FOV: 45 degrees · color fundus image — 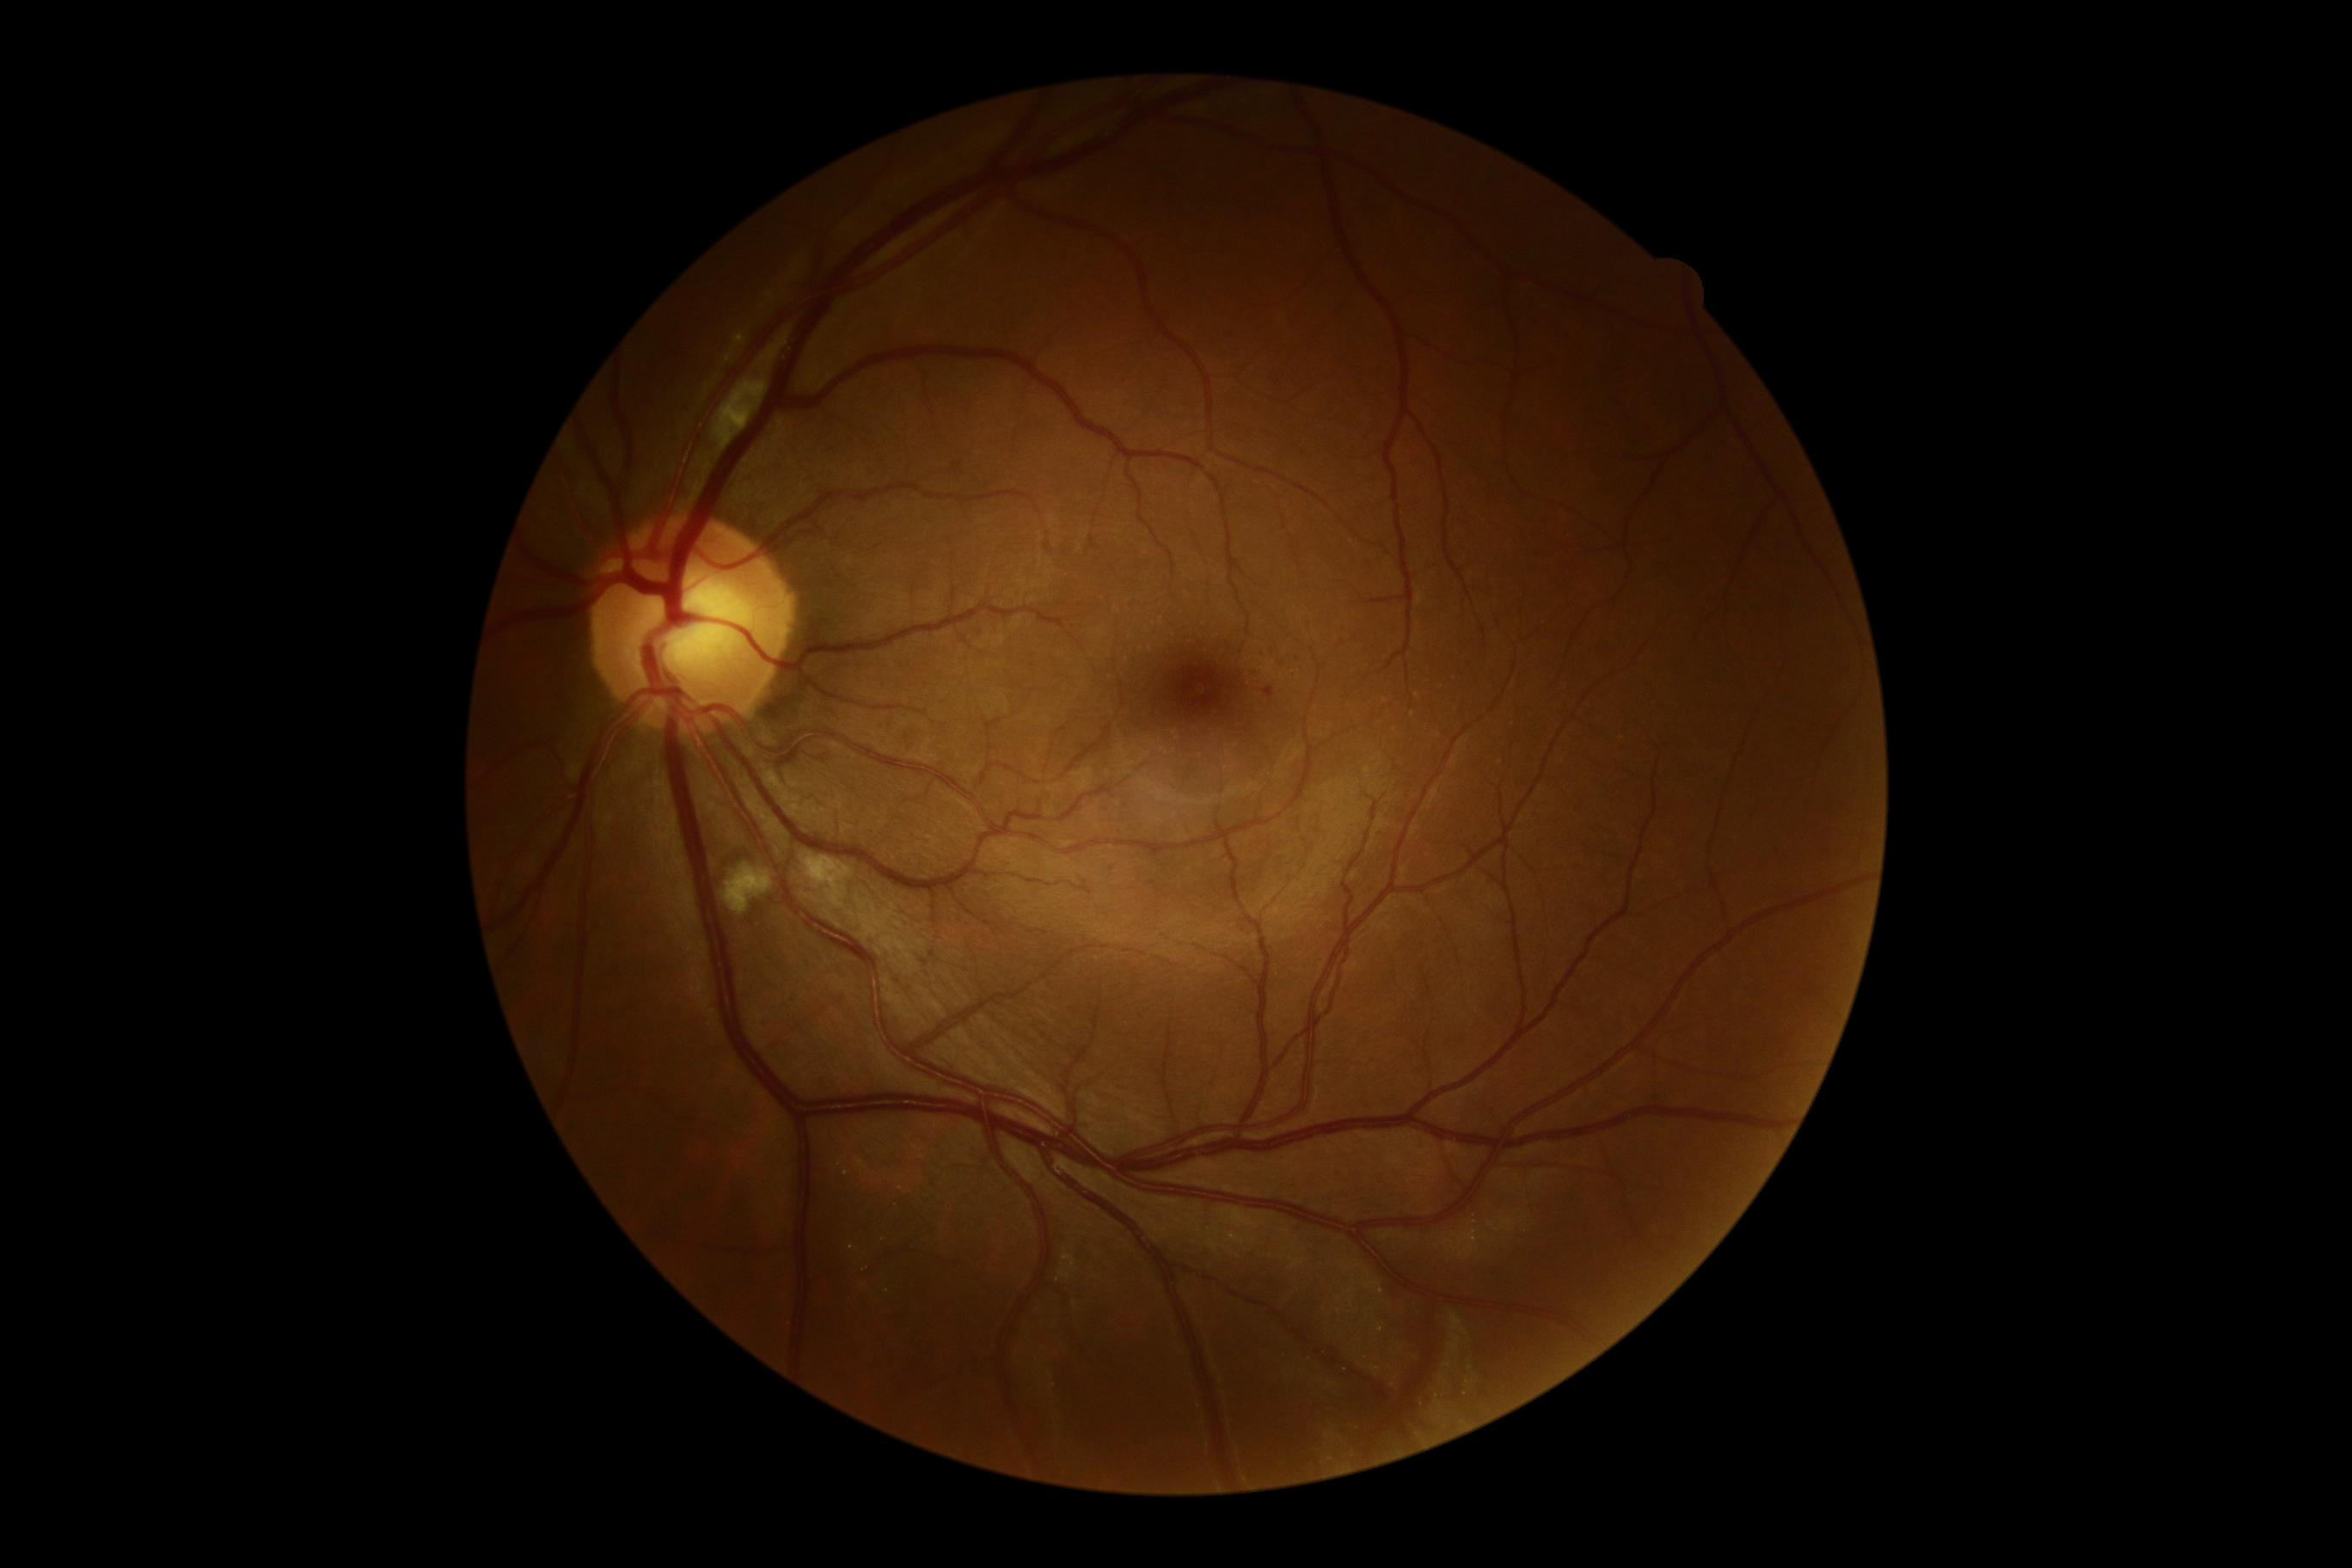

Diabetic retinopathy grade is 2/4; non-proliferative diabetic retinopathy
hemorrhages: absent
soft exudates: box(804, 855, 852, 907) | box(726, 864, 773, 914) | box(714, 379, 768, 450)
microaneurysms: box(1265, 689, 1275, 697)
hard exudates: absent